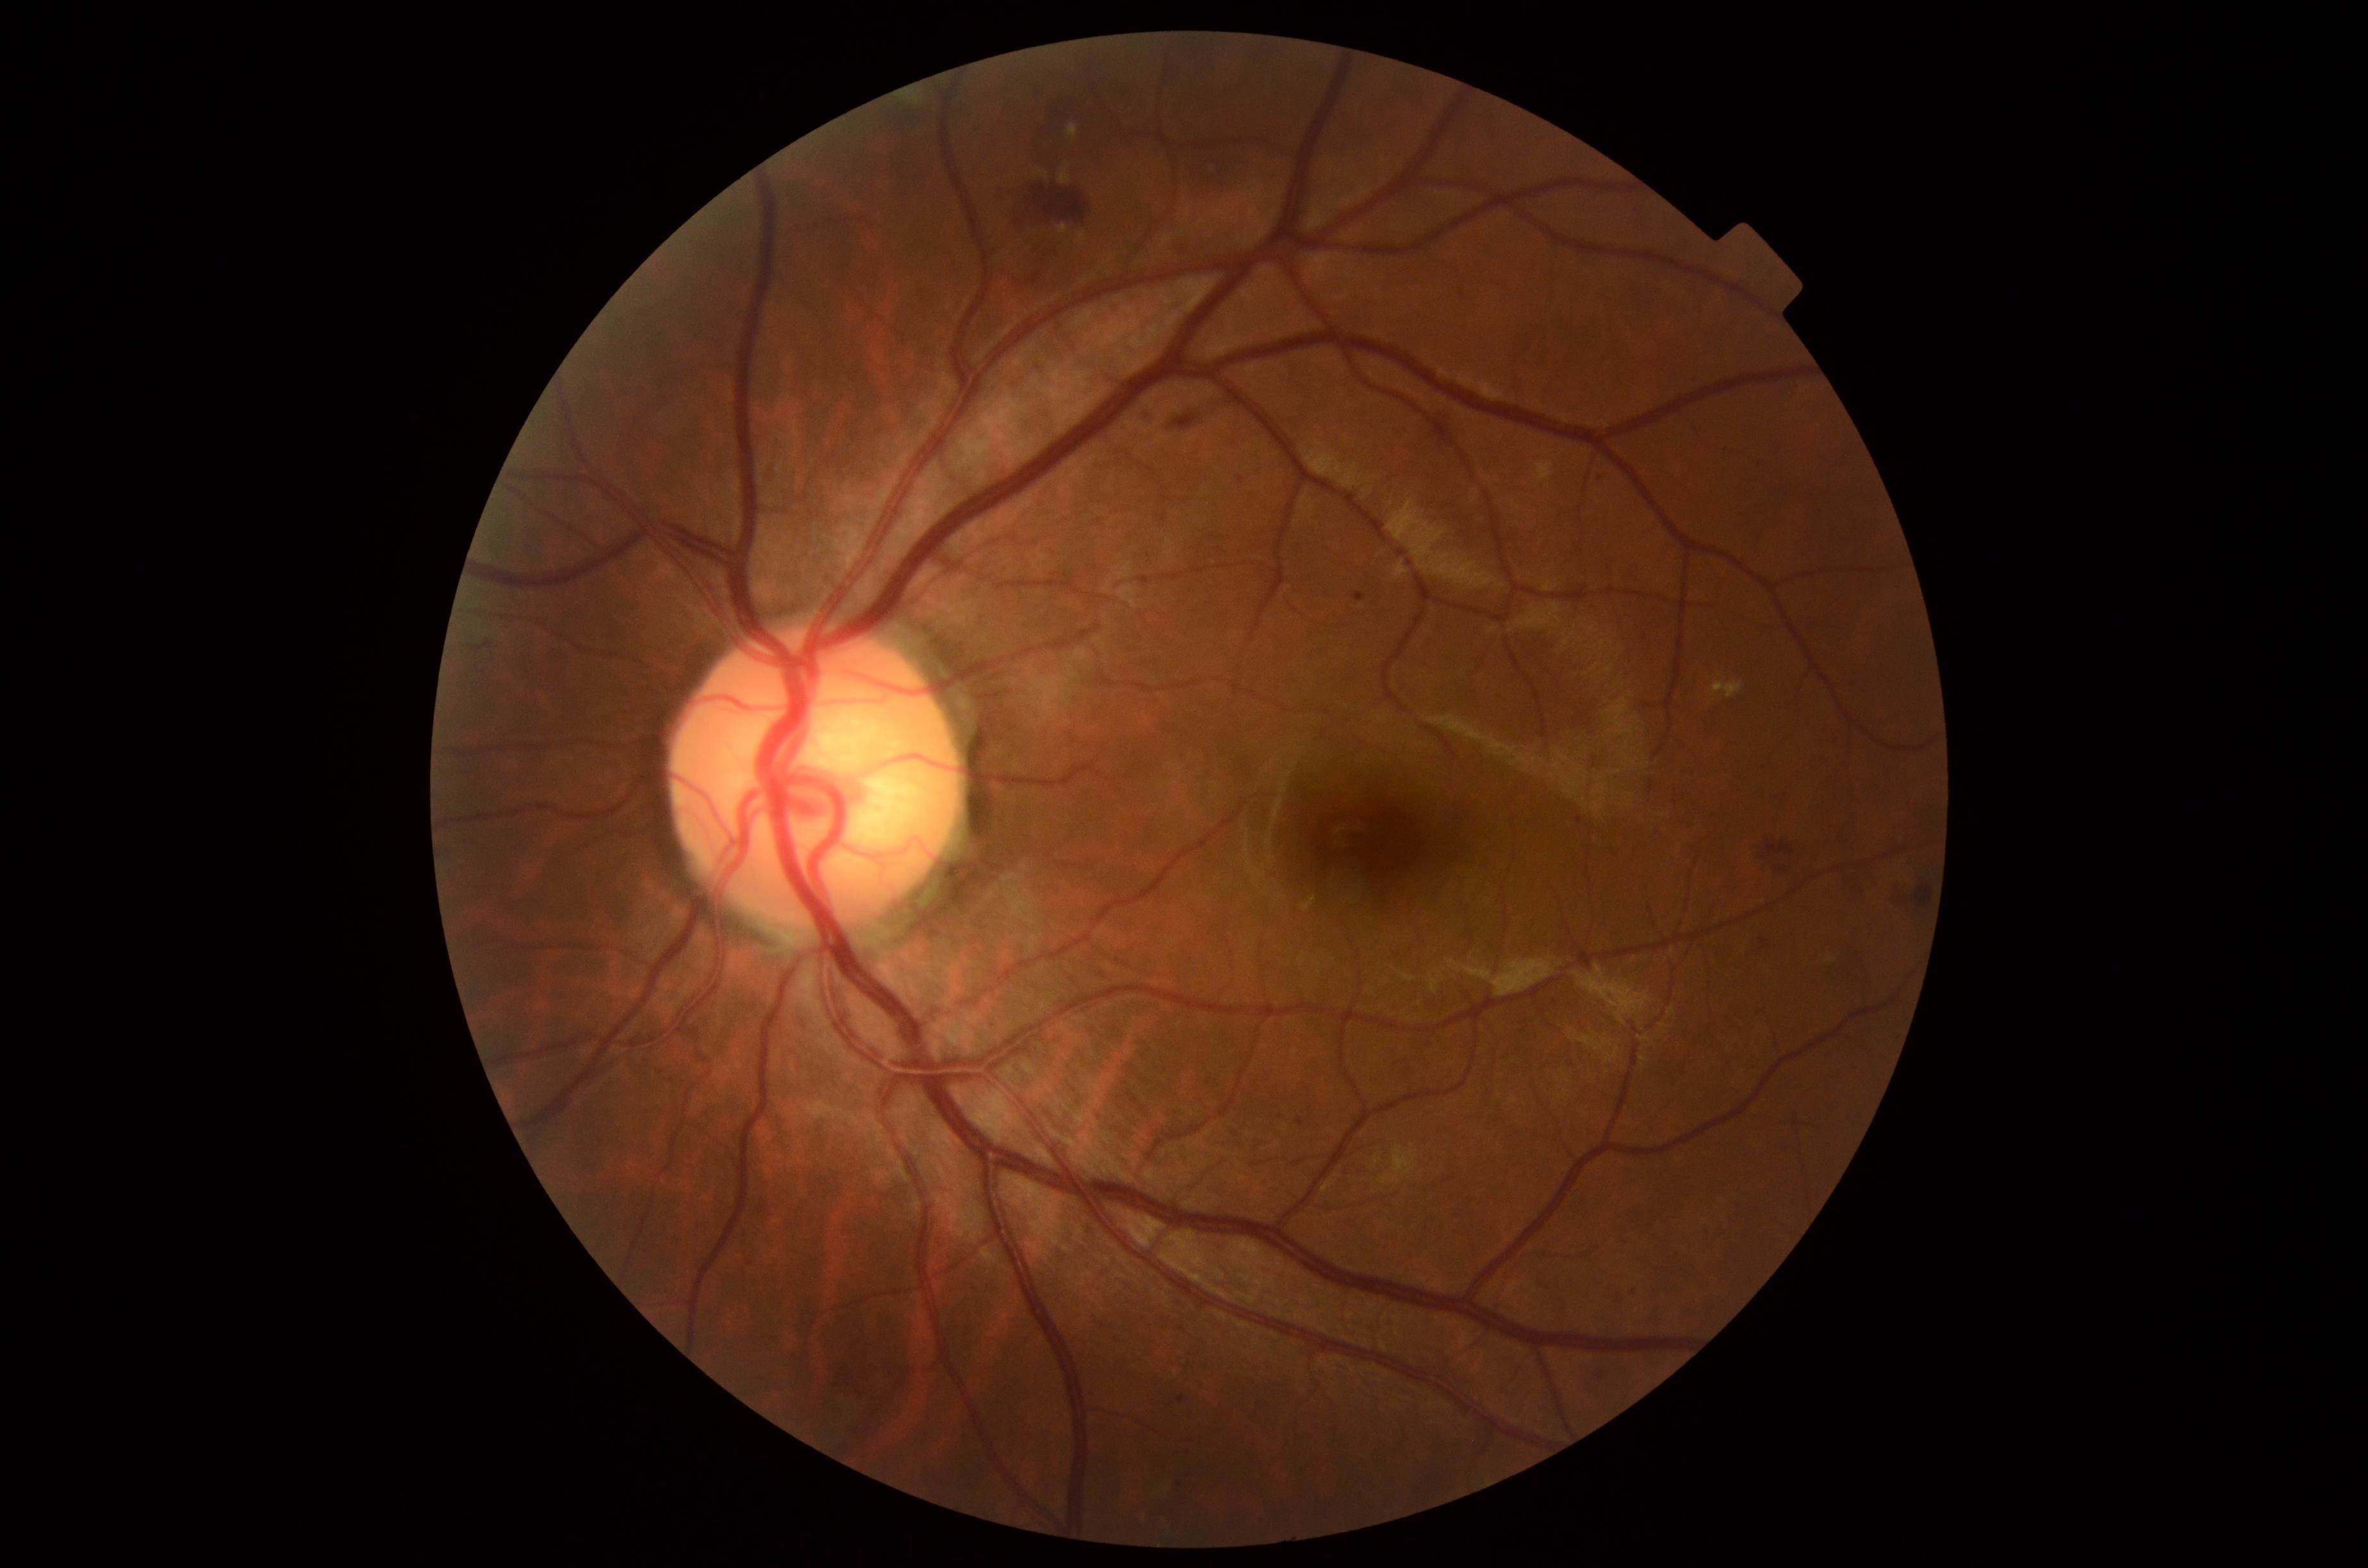 dr_grade: 2
lesions:
  ma:
    - 1296/1118/1305/1127
    - 1178/1394/1186/1402
    - 1353/592/1365/604
    - 1577/817/1584/826
  ma_small:
    - (1182,1327)
    - (1600,478)
  he:
    - 473/641/494/651
    - 1766/841/1793/856
    - 1171/414/1199/431
    - 1915/886/1932/906
    - 1036/188/1090/221
    - 1048/99/1067/116
    - 1770/865/1789/874
  se: []
  ex:
    - 1711/680/1743/699
    - 1067/125/1080/138
    - 1058/166/1072/185
    - 1057/225/1071/235
    - 1035/168/1049/180
    - 1080/233/1085/241